Image size 2352x1568.
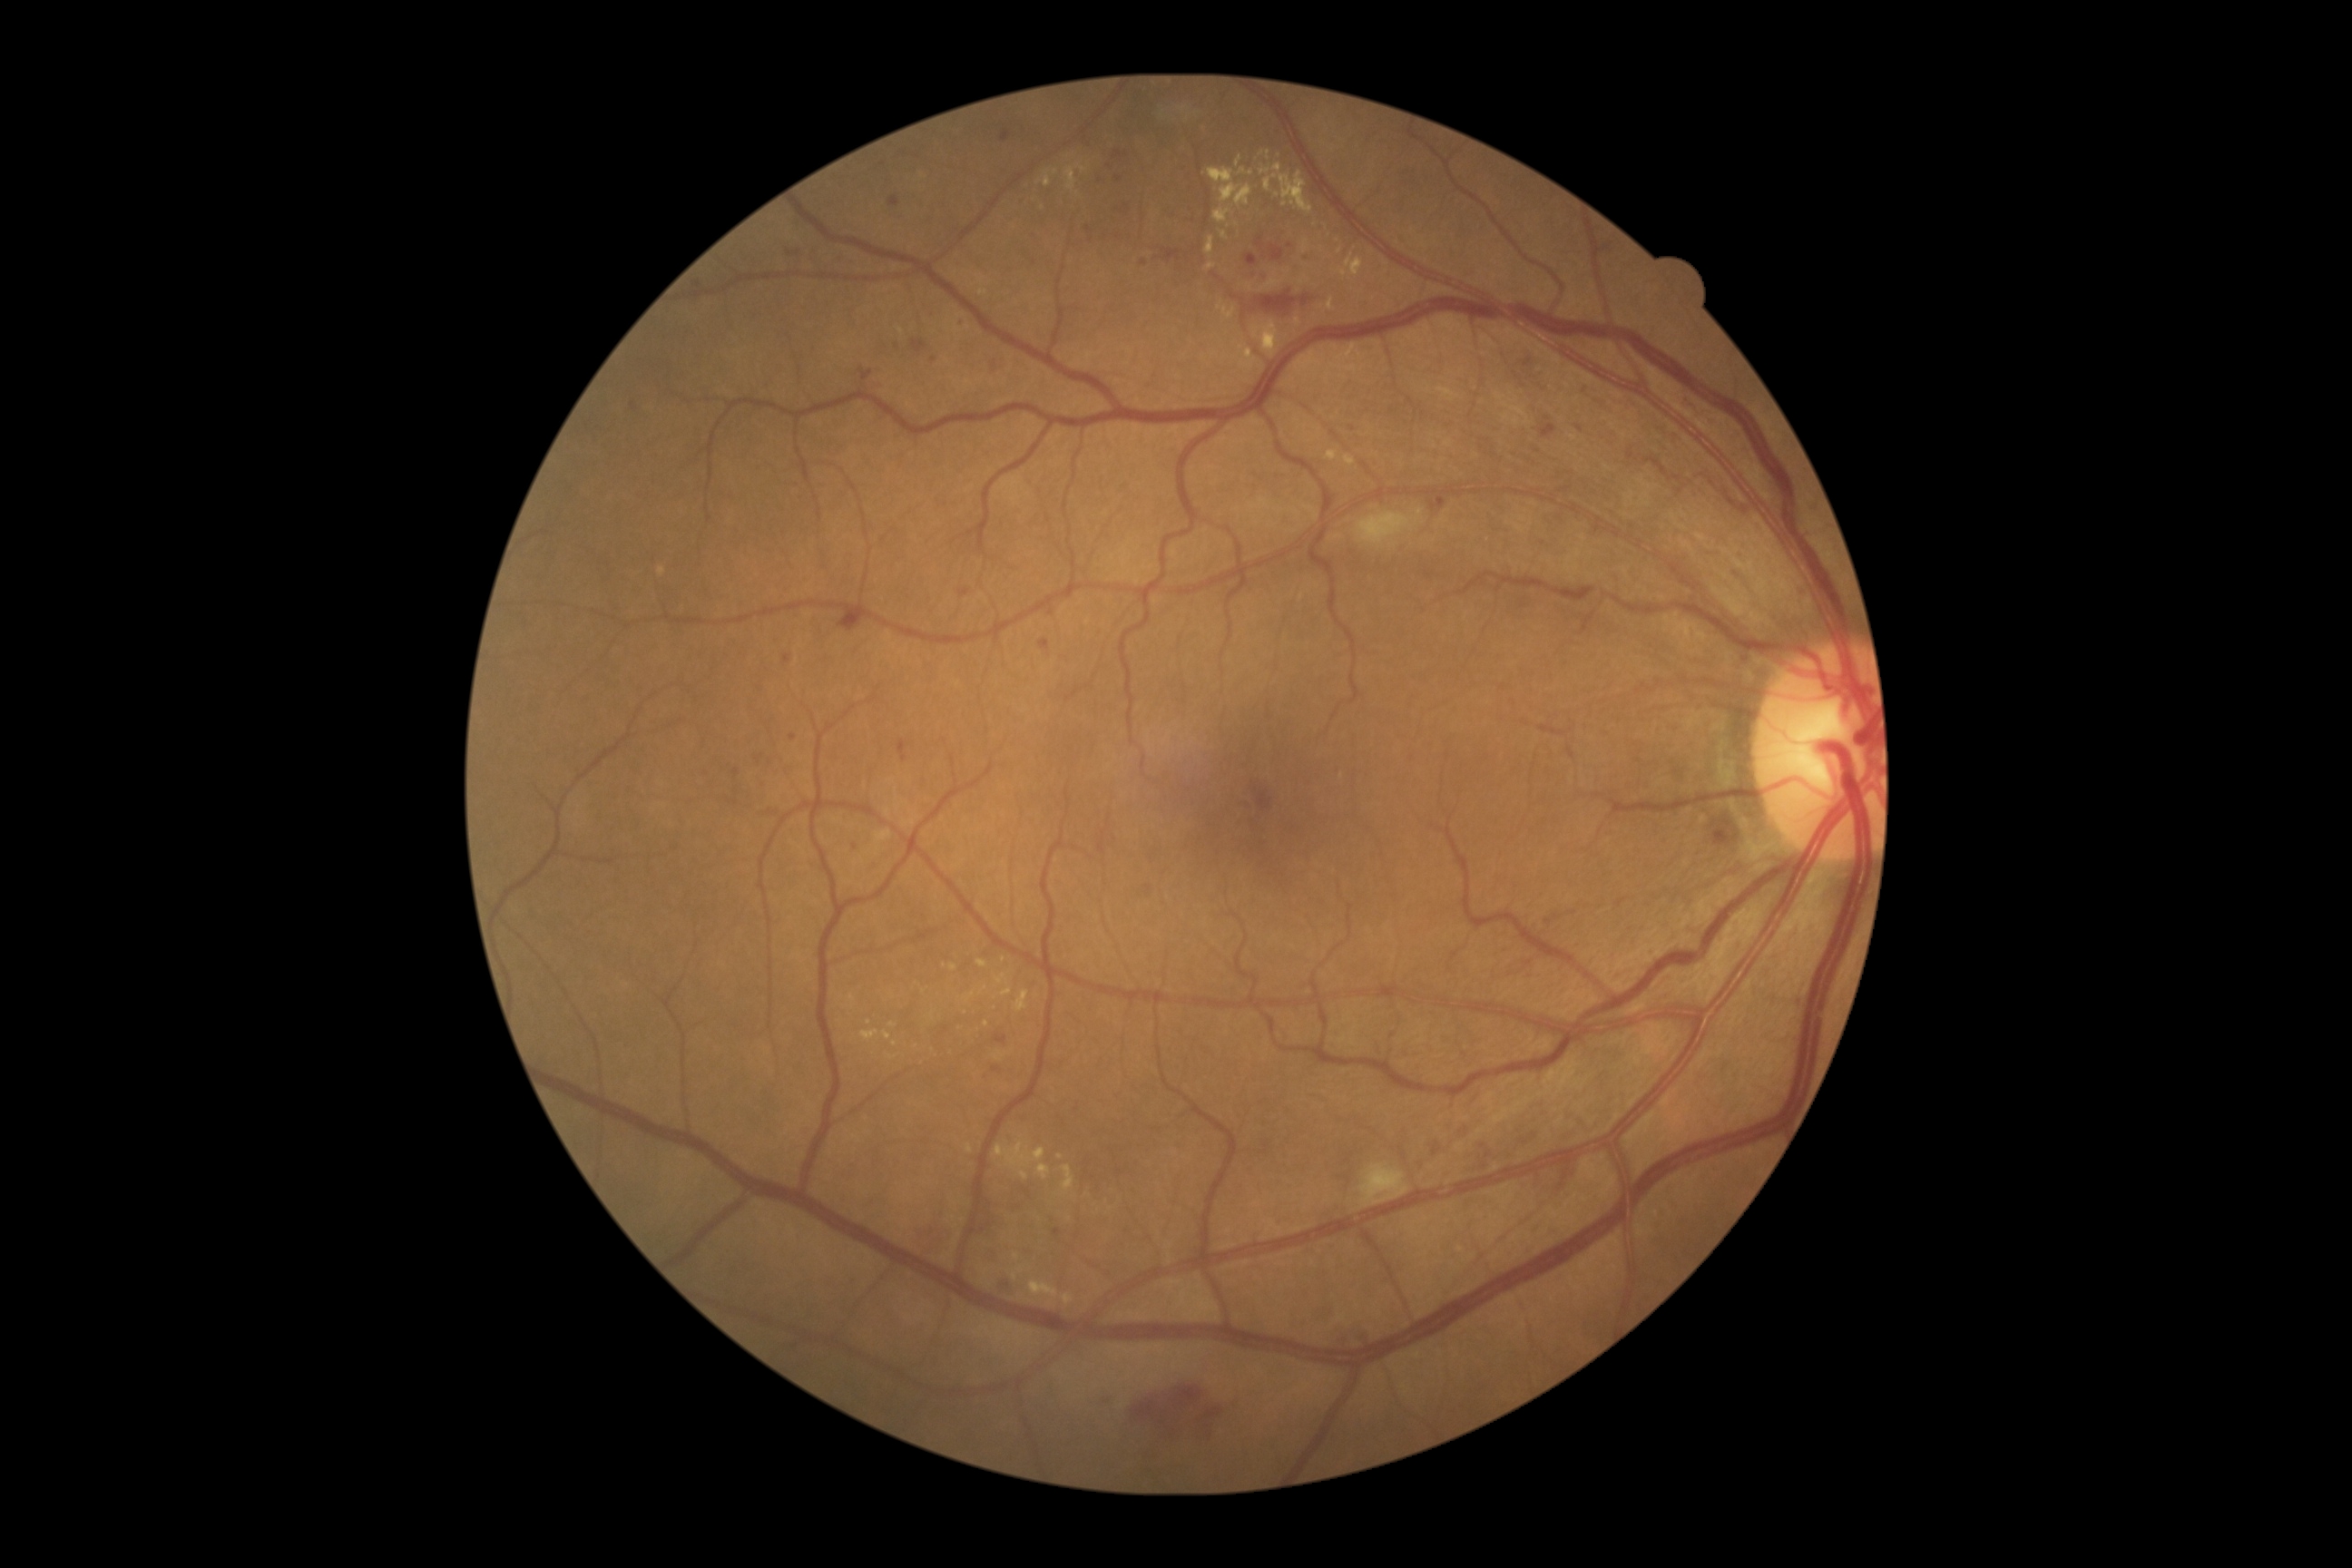
DR stage is grade 2 (moderate NPDR).
EXs are present, including at region(850, 995, 856, 1003) | region(965, 992, 975, 1003) | region(883, 1032, 892, 1041) | region(1326, 299, 1337, 311) | region(1037, 1164, 1050, 1181) | region(1235, 184, 1253, 206) | region(977, 961, 988, 968) | region(1206, 262, 1217, 271) | region(1064, 162, 1088, 191) | region(1219, 302, 1235, 320) | region(1206, 237, 1215, 257) | region(966, 1144, 974, 1153) | region(1208, 168, 1240, 204).
Smaller EXs around pt(1286, 204) | pt(953, 968) | pt(1004, 960) | pt(1039, 955) | pt(894, 1043).